Acquired with a NIDEK AFC-230. Color fundus photograph:
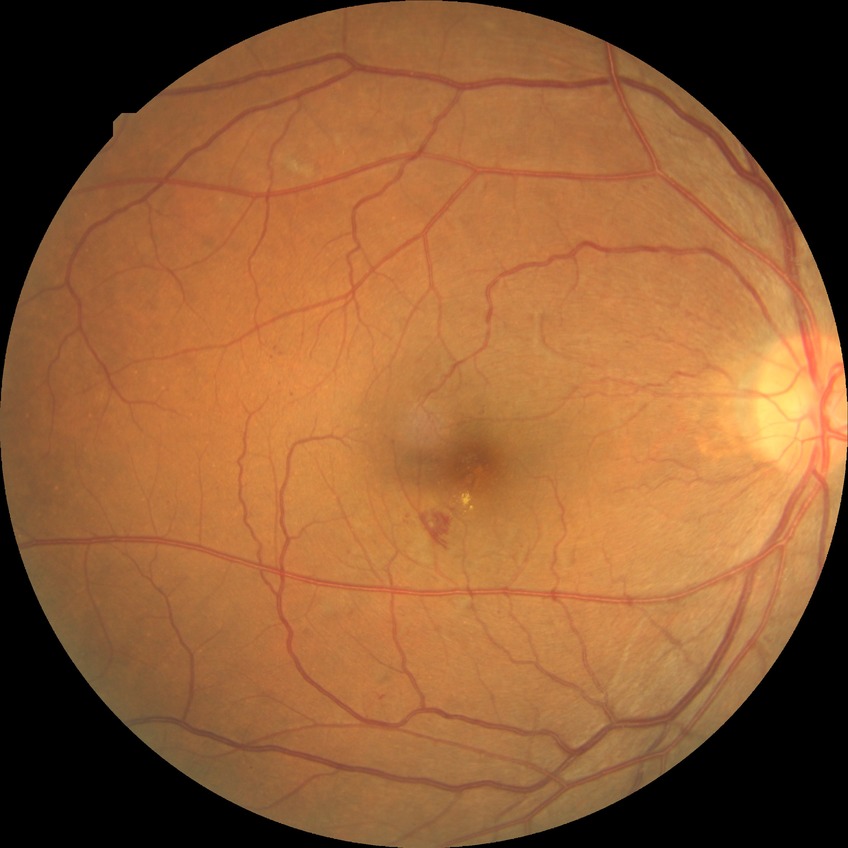

Diabetic retinopathy (DR) is SDR (simple diabetic retinopathy).